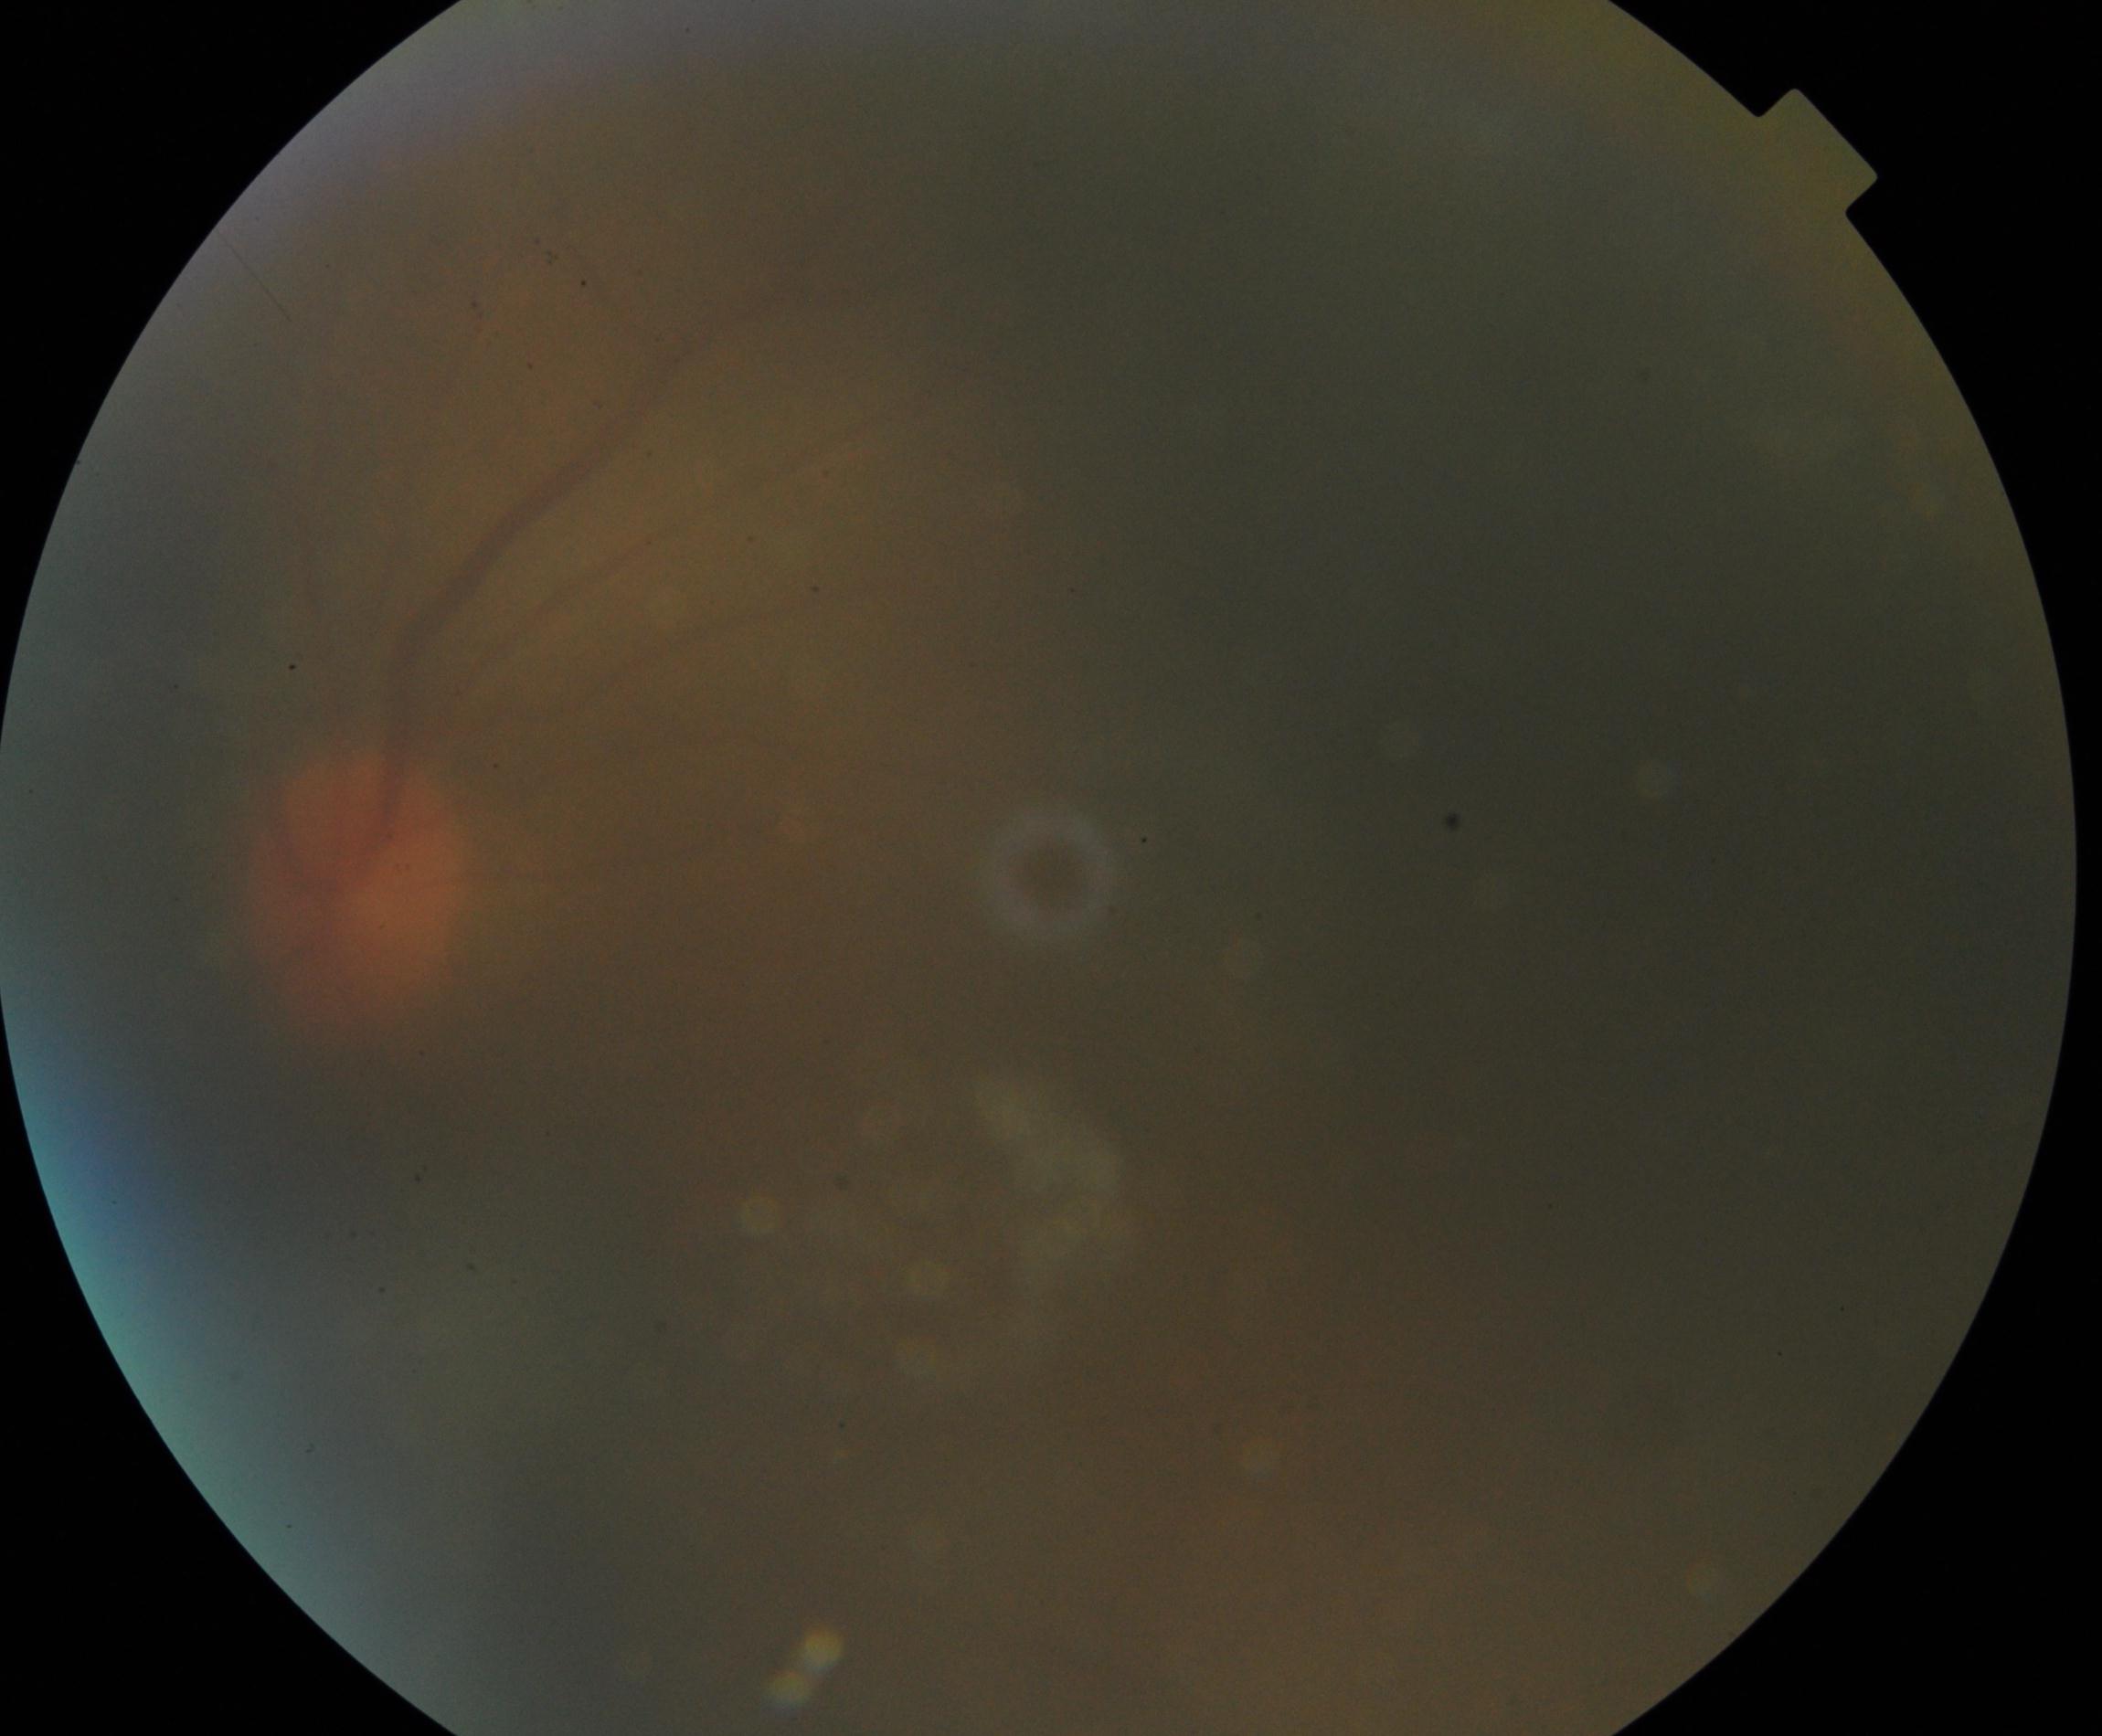 Gradability: significantly degraded.
Proliferative diabetic retinopathy: not identified.